Modified Davis grading
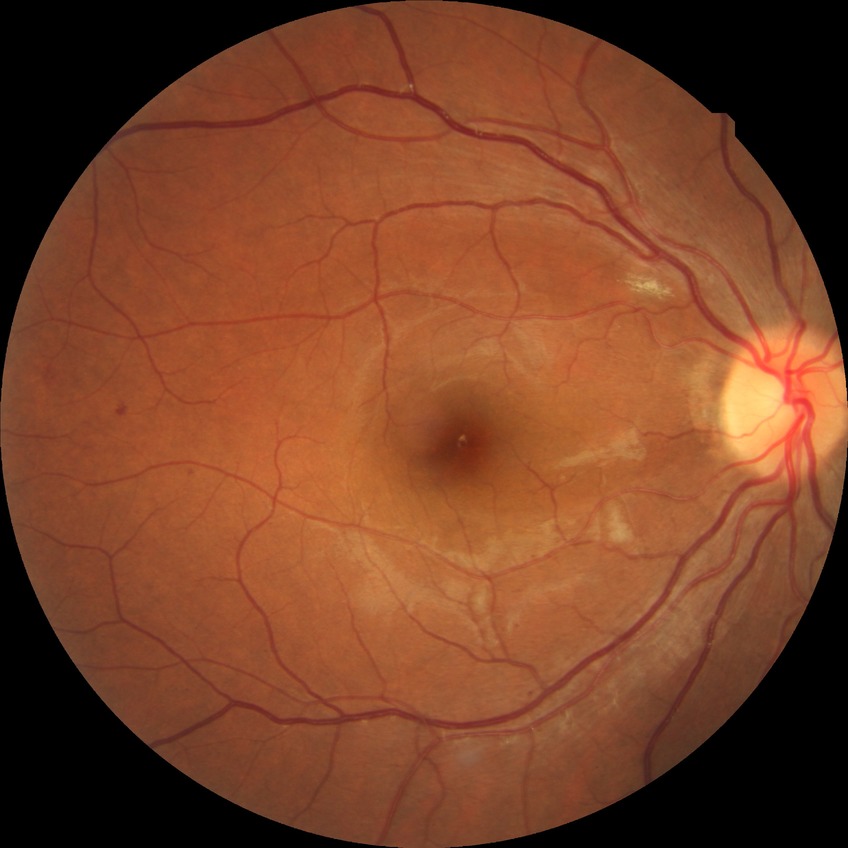

Davis grade: NDR.